1932 by 1932 pixels.
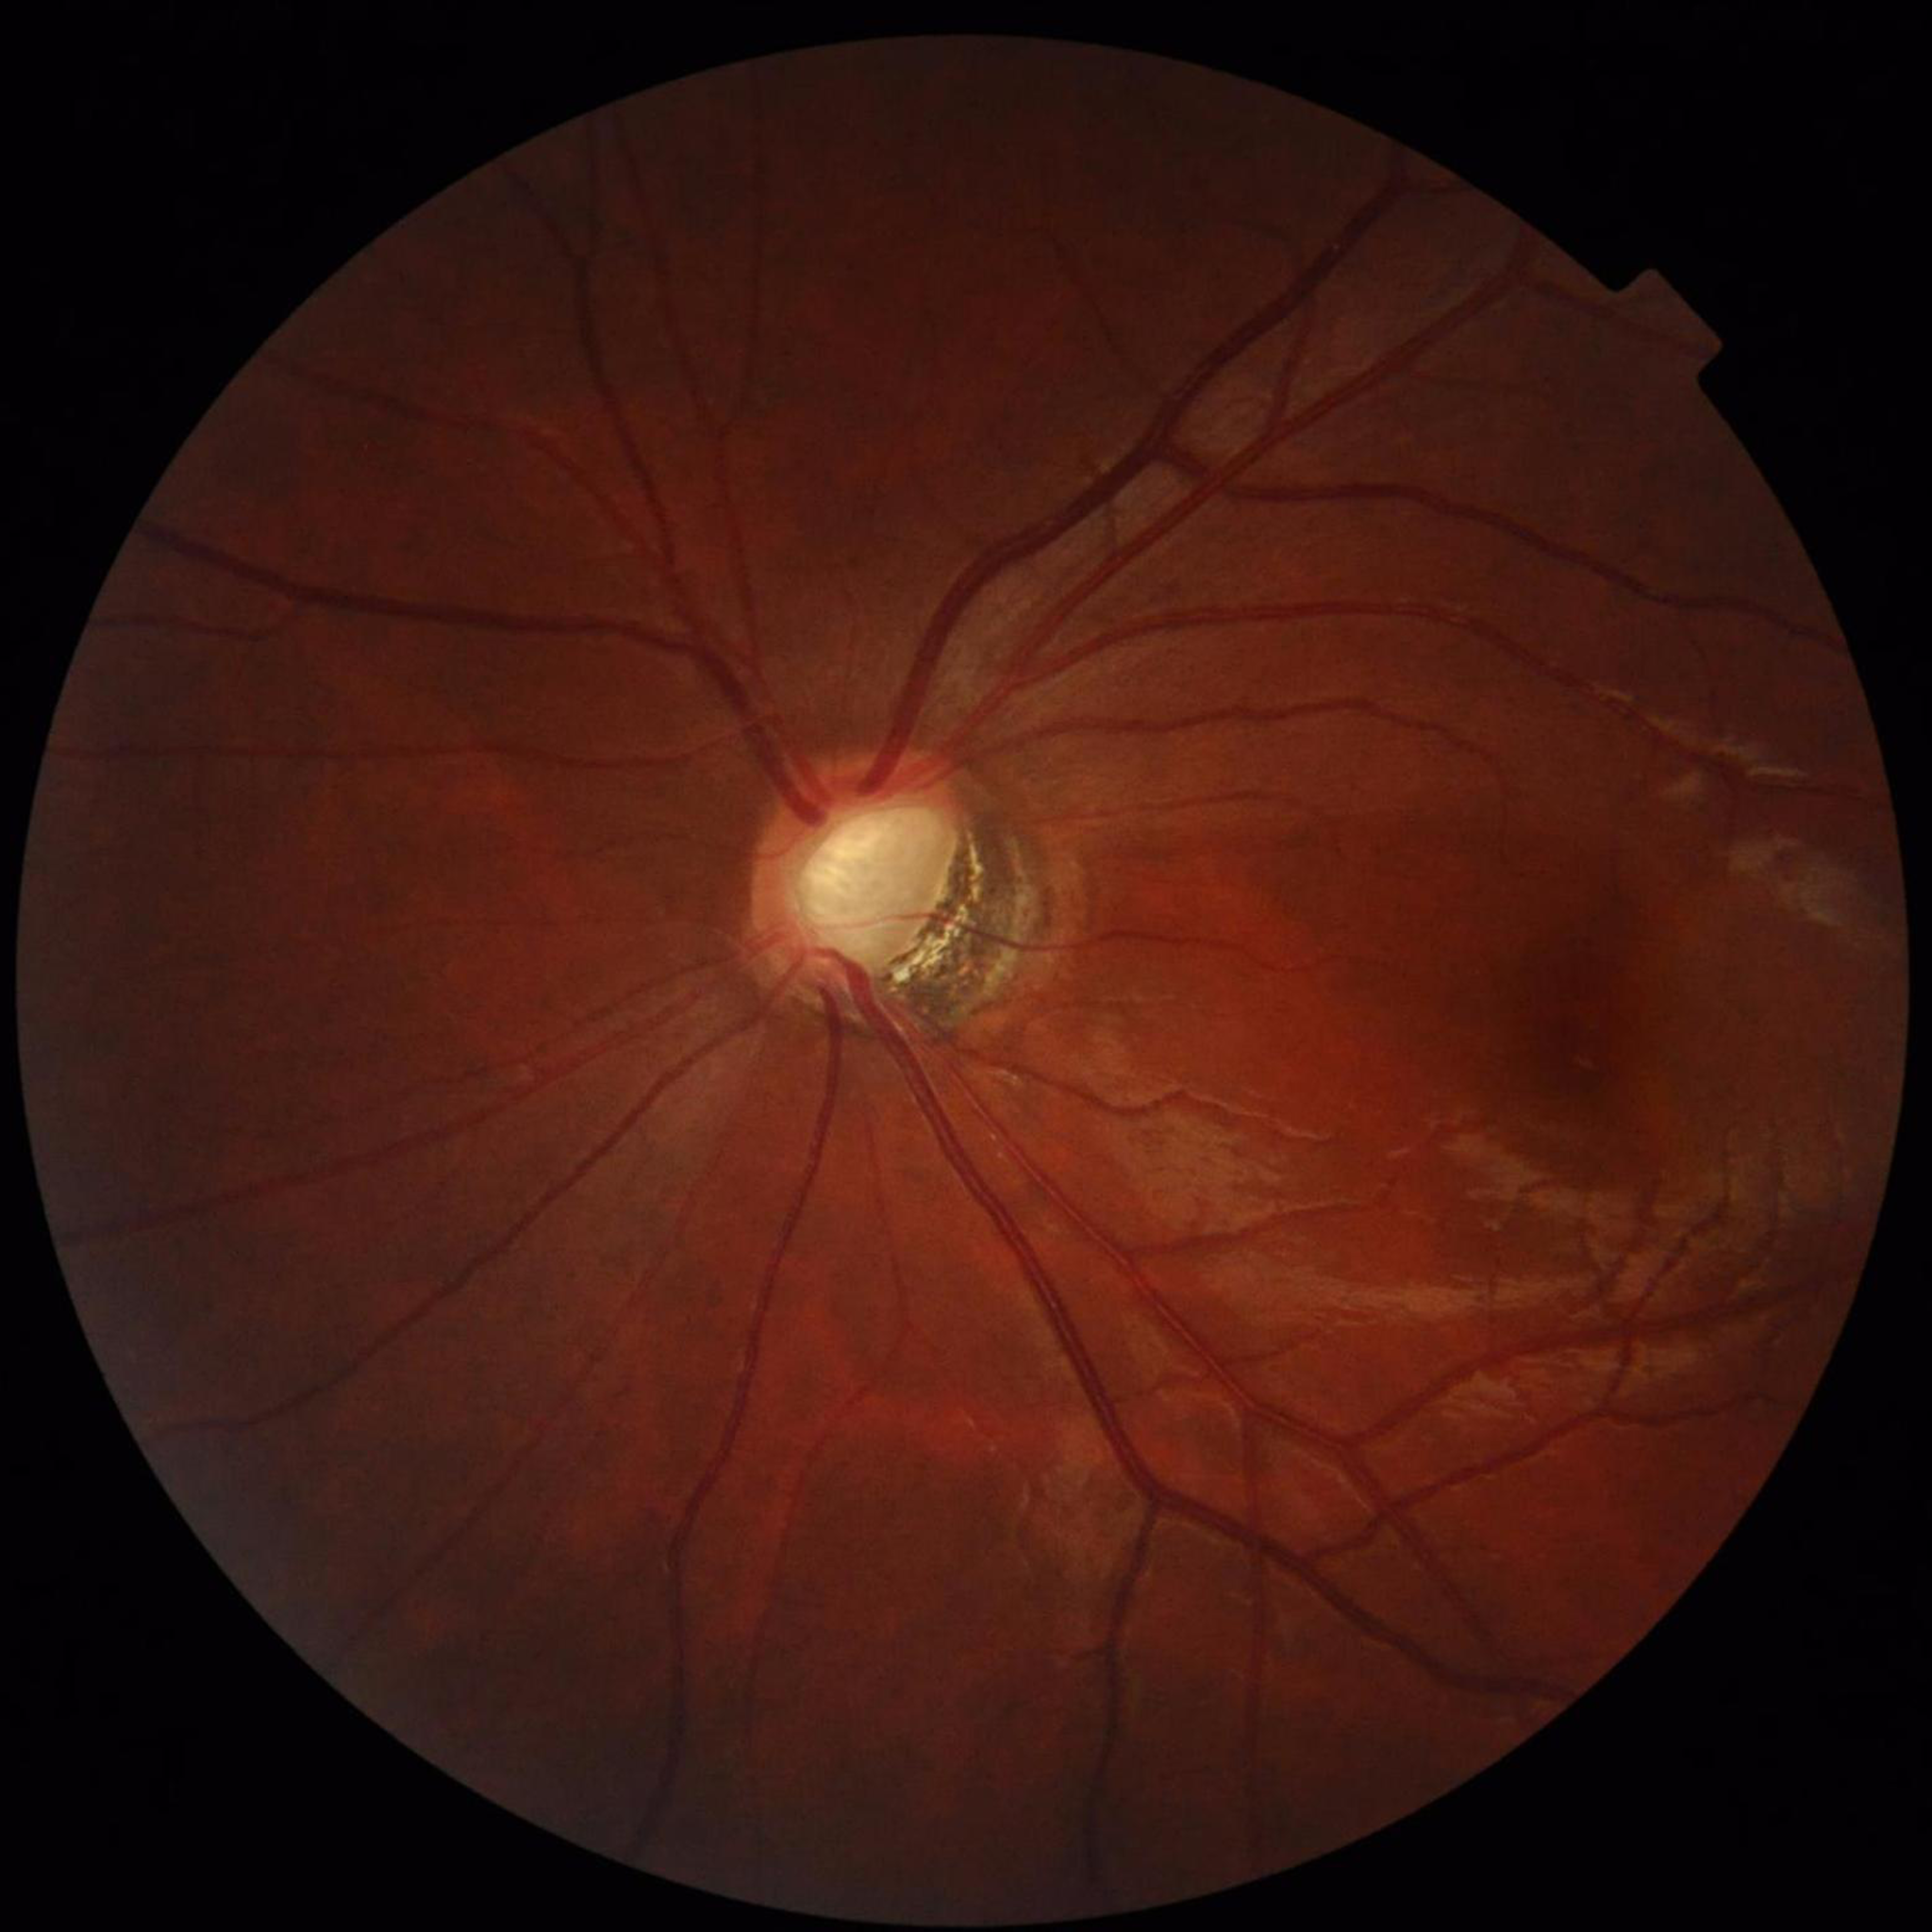

The patient was diagnosed with glaucoma.